Color fundus photograph
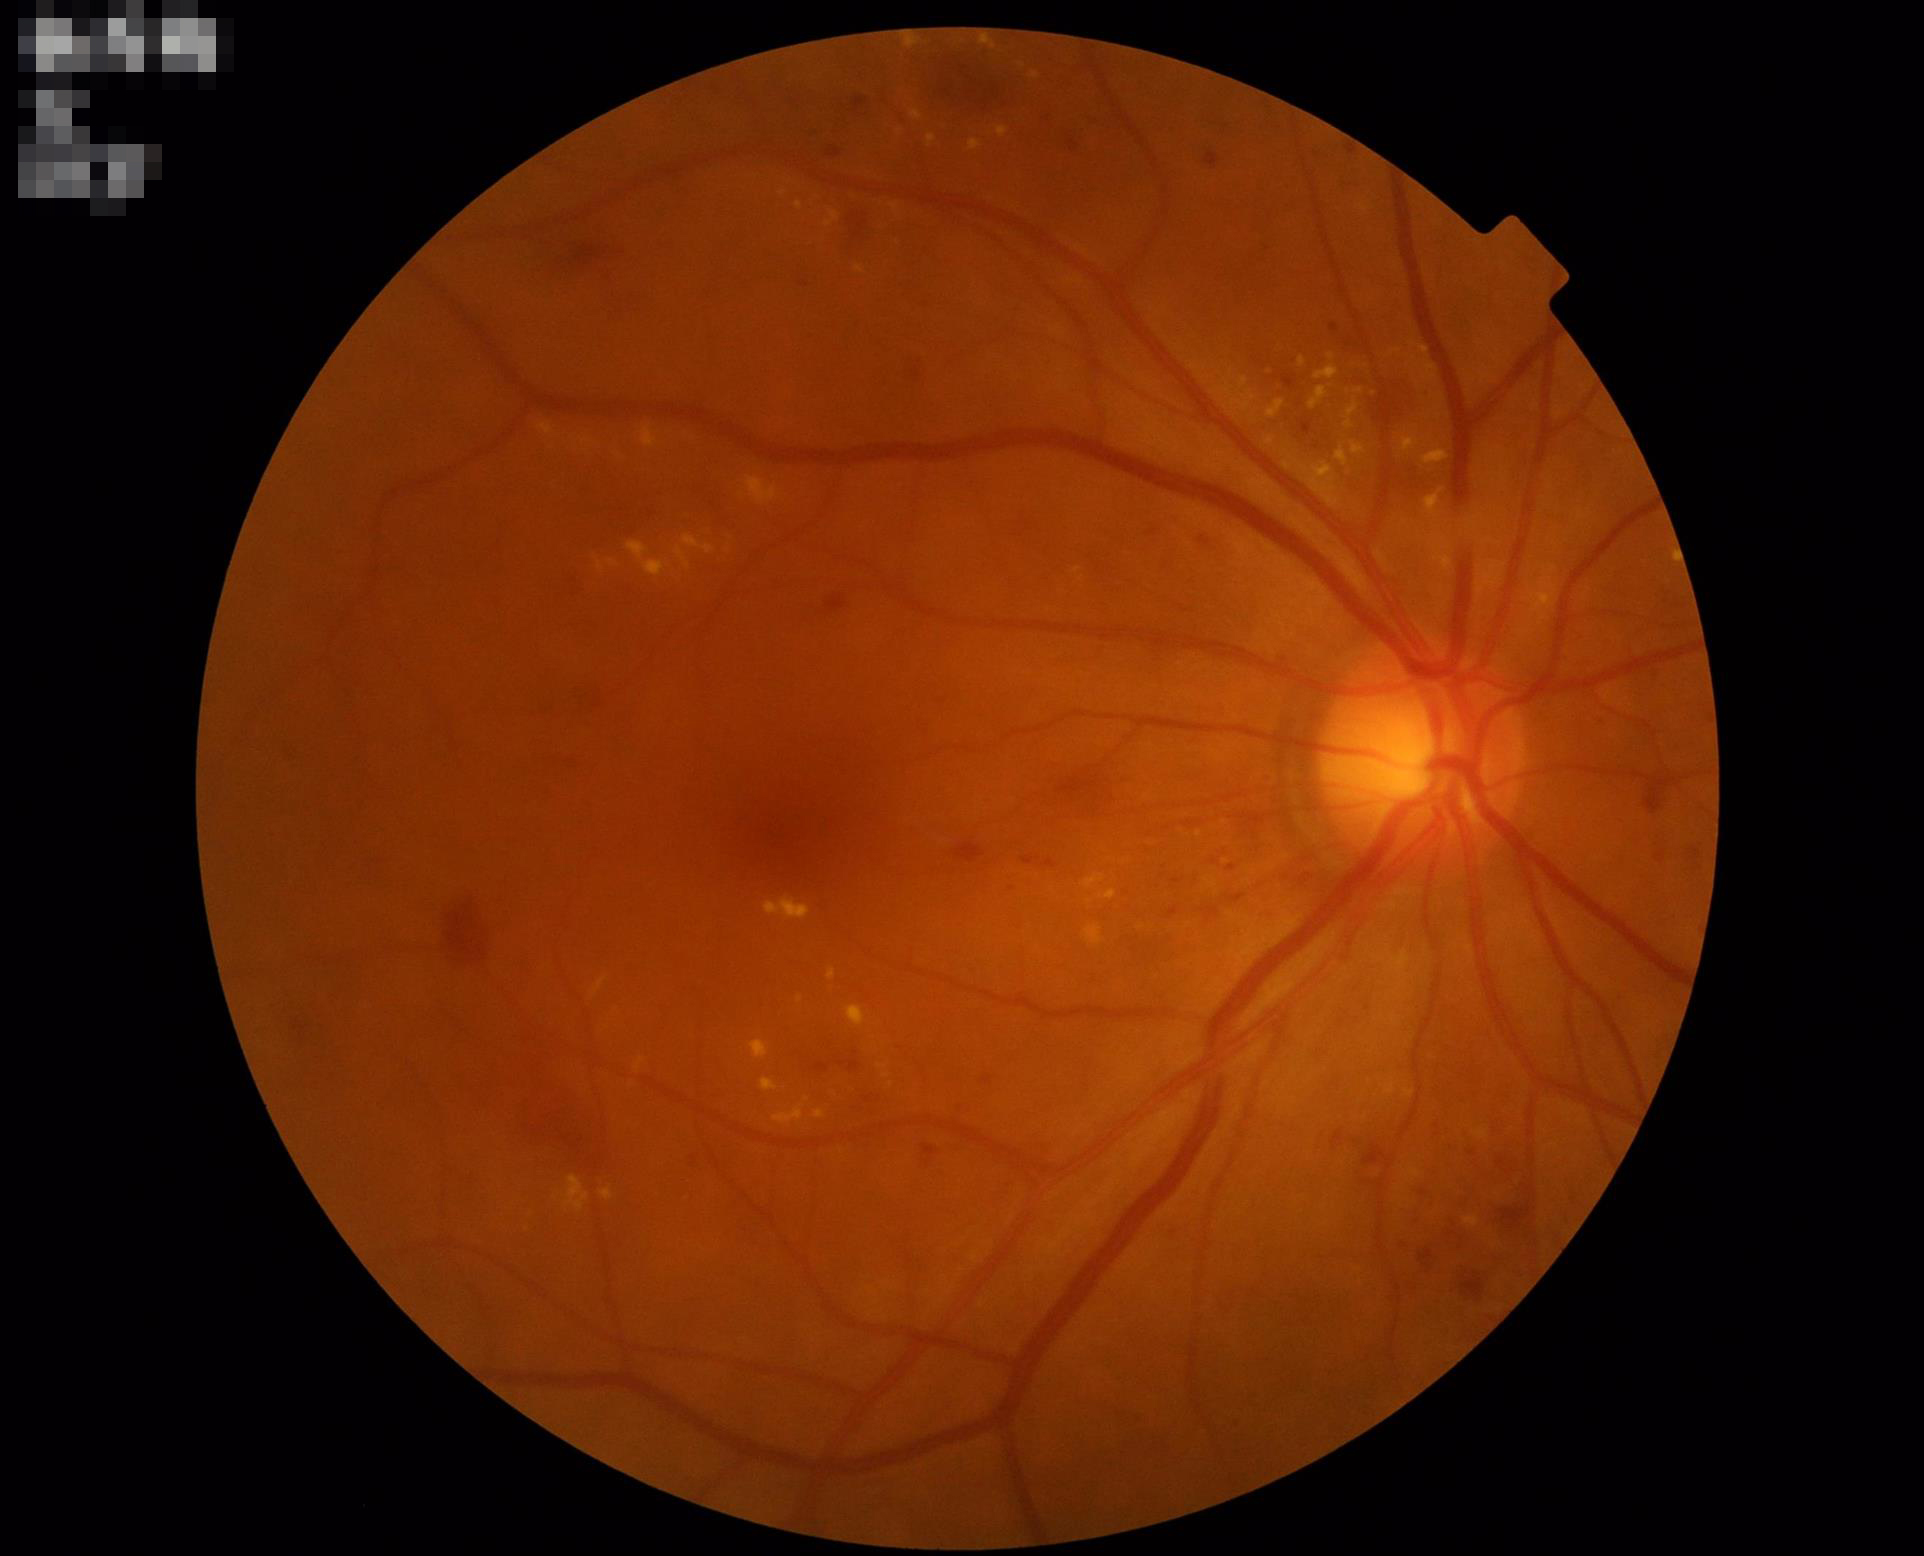
Image is sharp throughout the field. Illumination is even. Overall quality is good and the image is gradable. Good dynamic range.